640x480; camera: Clarity RetCam 3 (130° FOV); wide-field fundus photograph of an infant.
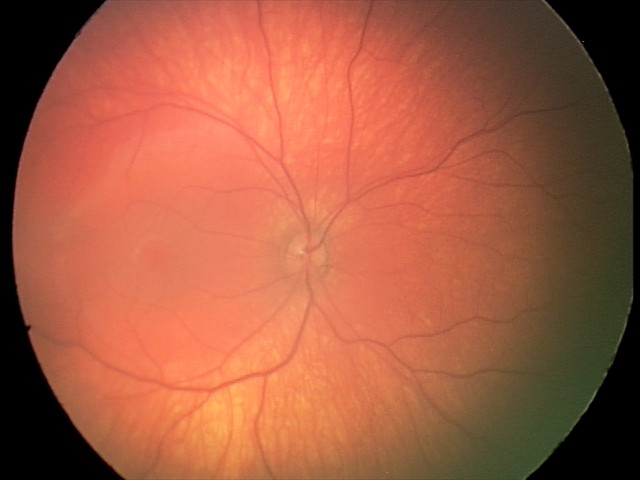
No retinal pathology identified on screening.